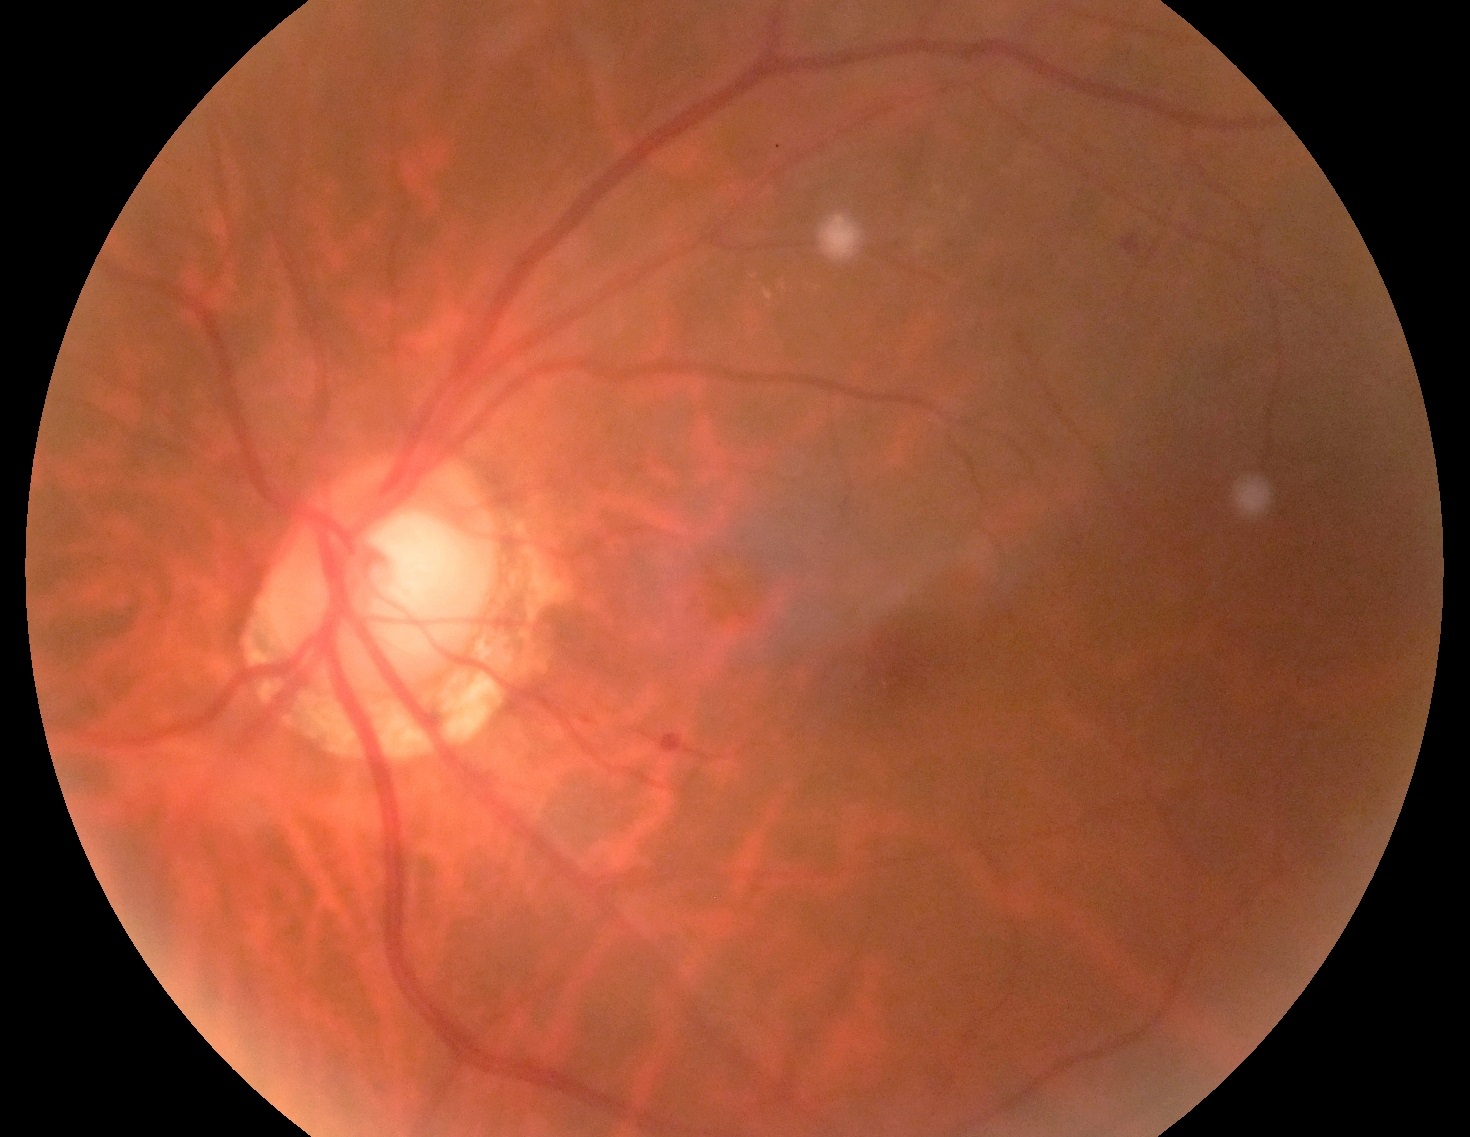

* diabetic retinopathy (DR) — grade 2